848 x 848 pixels; 45° field of view; without pupil dilation; posterior pole color fundus photograph; acquired with a NIDEK AFC-230:
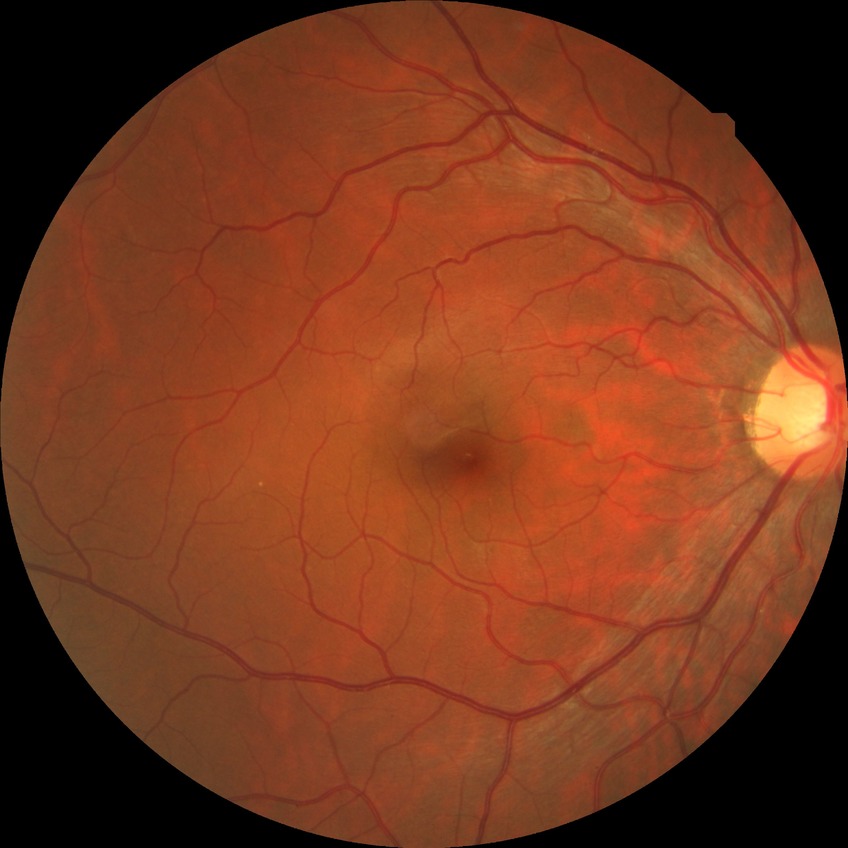
diabetic retinopathy (DR): NDR (no diabetic retinopathy).